Wide-field fundus image from infant ROP screening
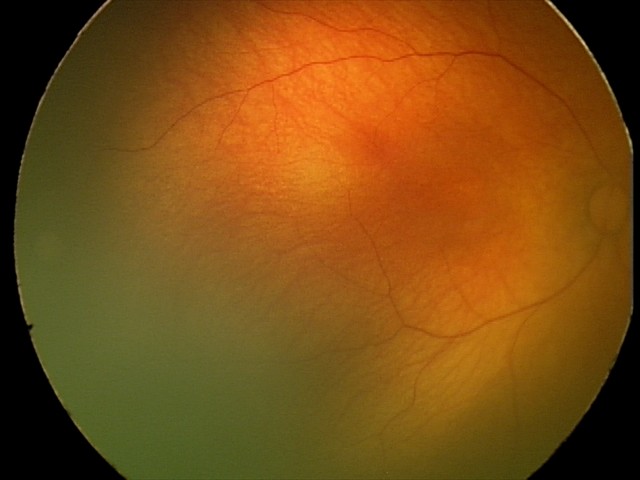
Assessment: physiological retinal finding.